Intraocular pressure (IOP): 18 mmHg. 62-year-old patient. Axial length 23.8 mm:
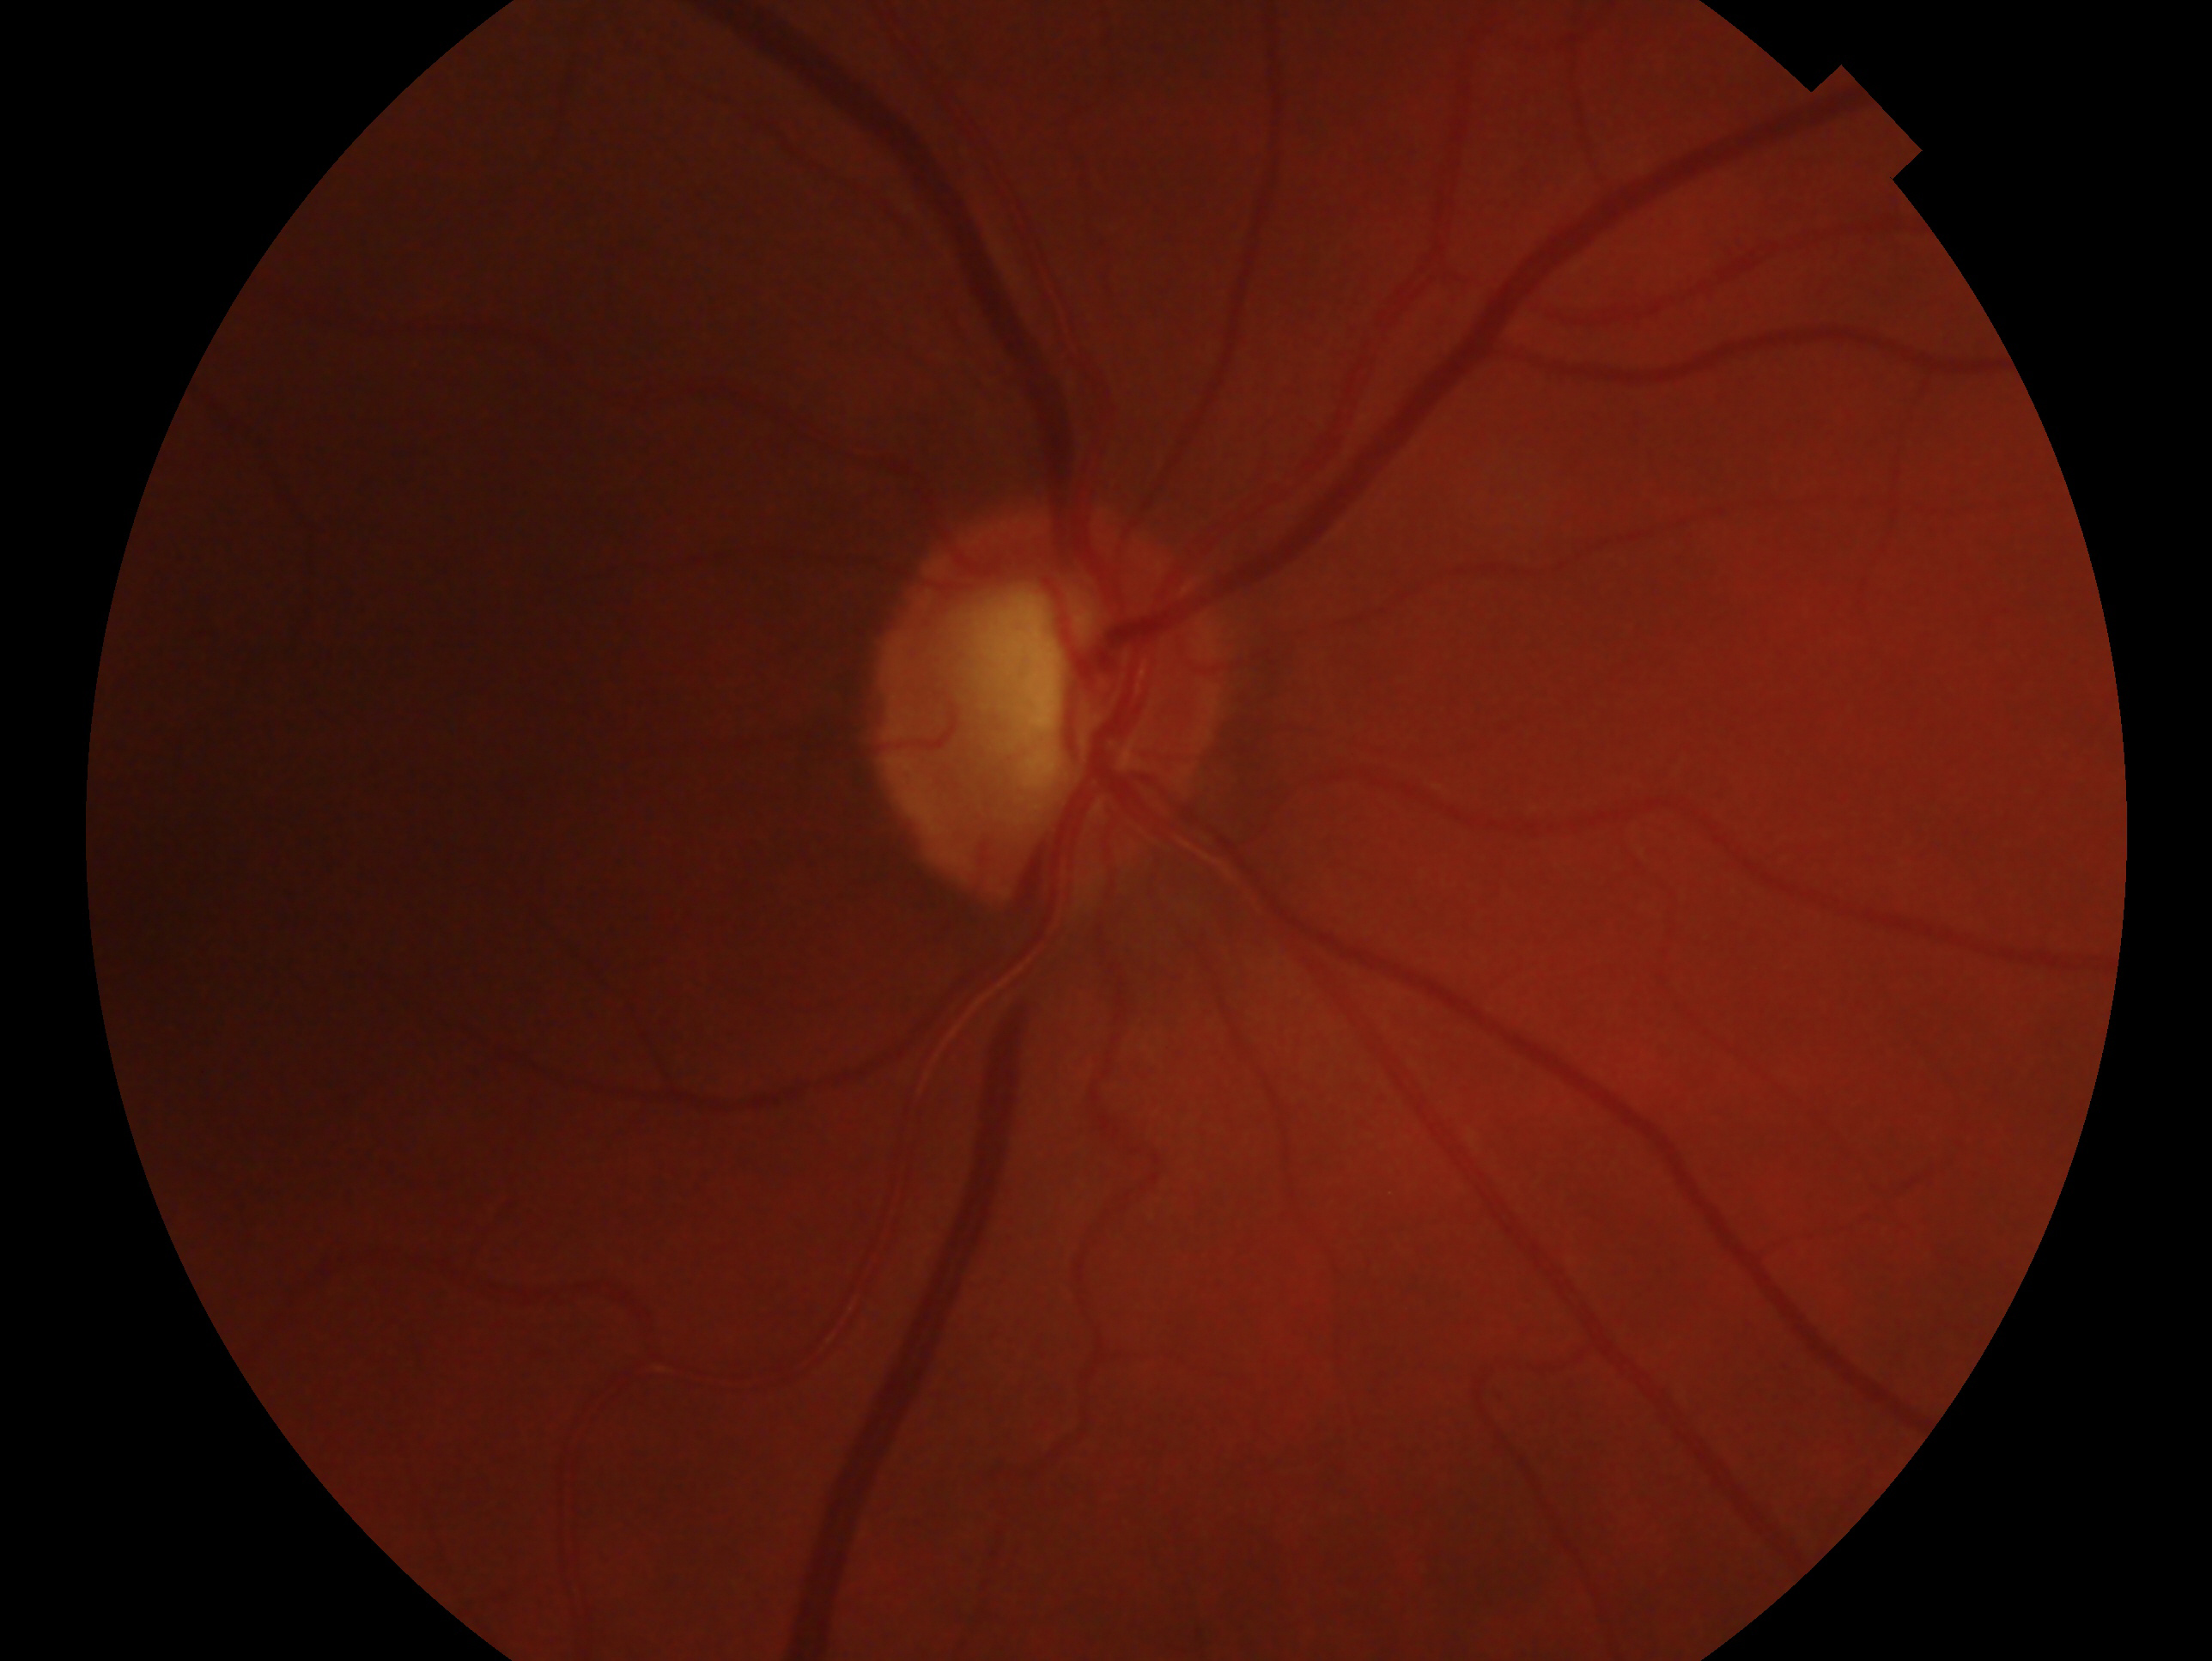

  glaucoma_dx: glaucoma
  eye: right eye